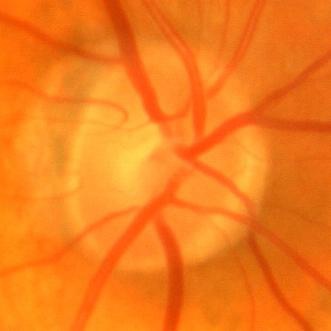 The image shows no glaucomatous changes.